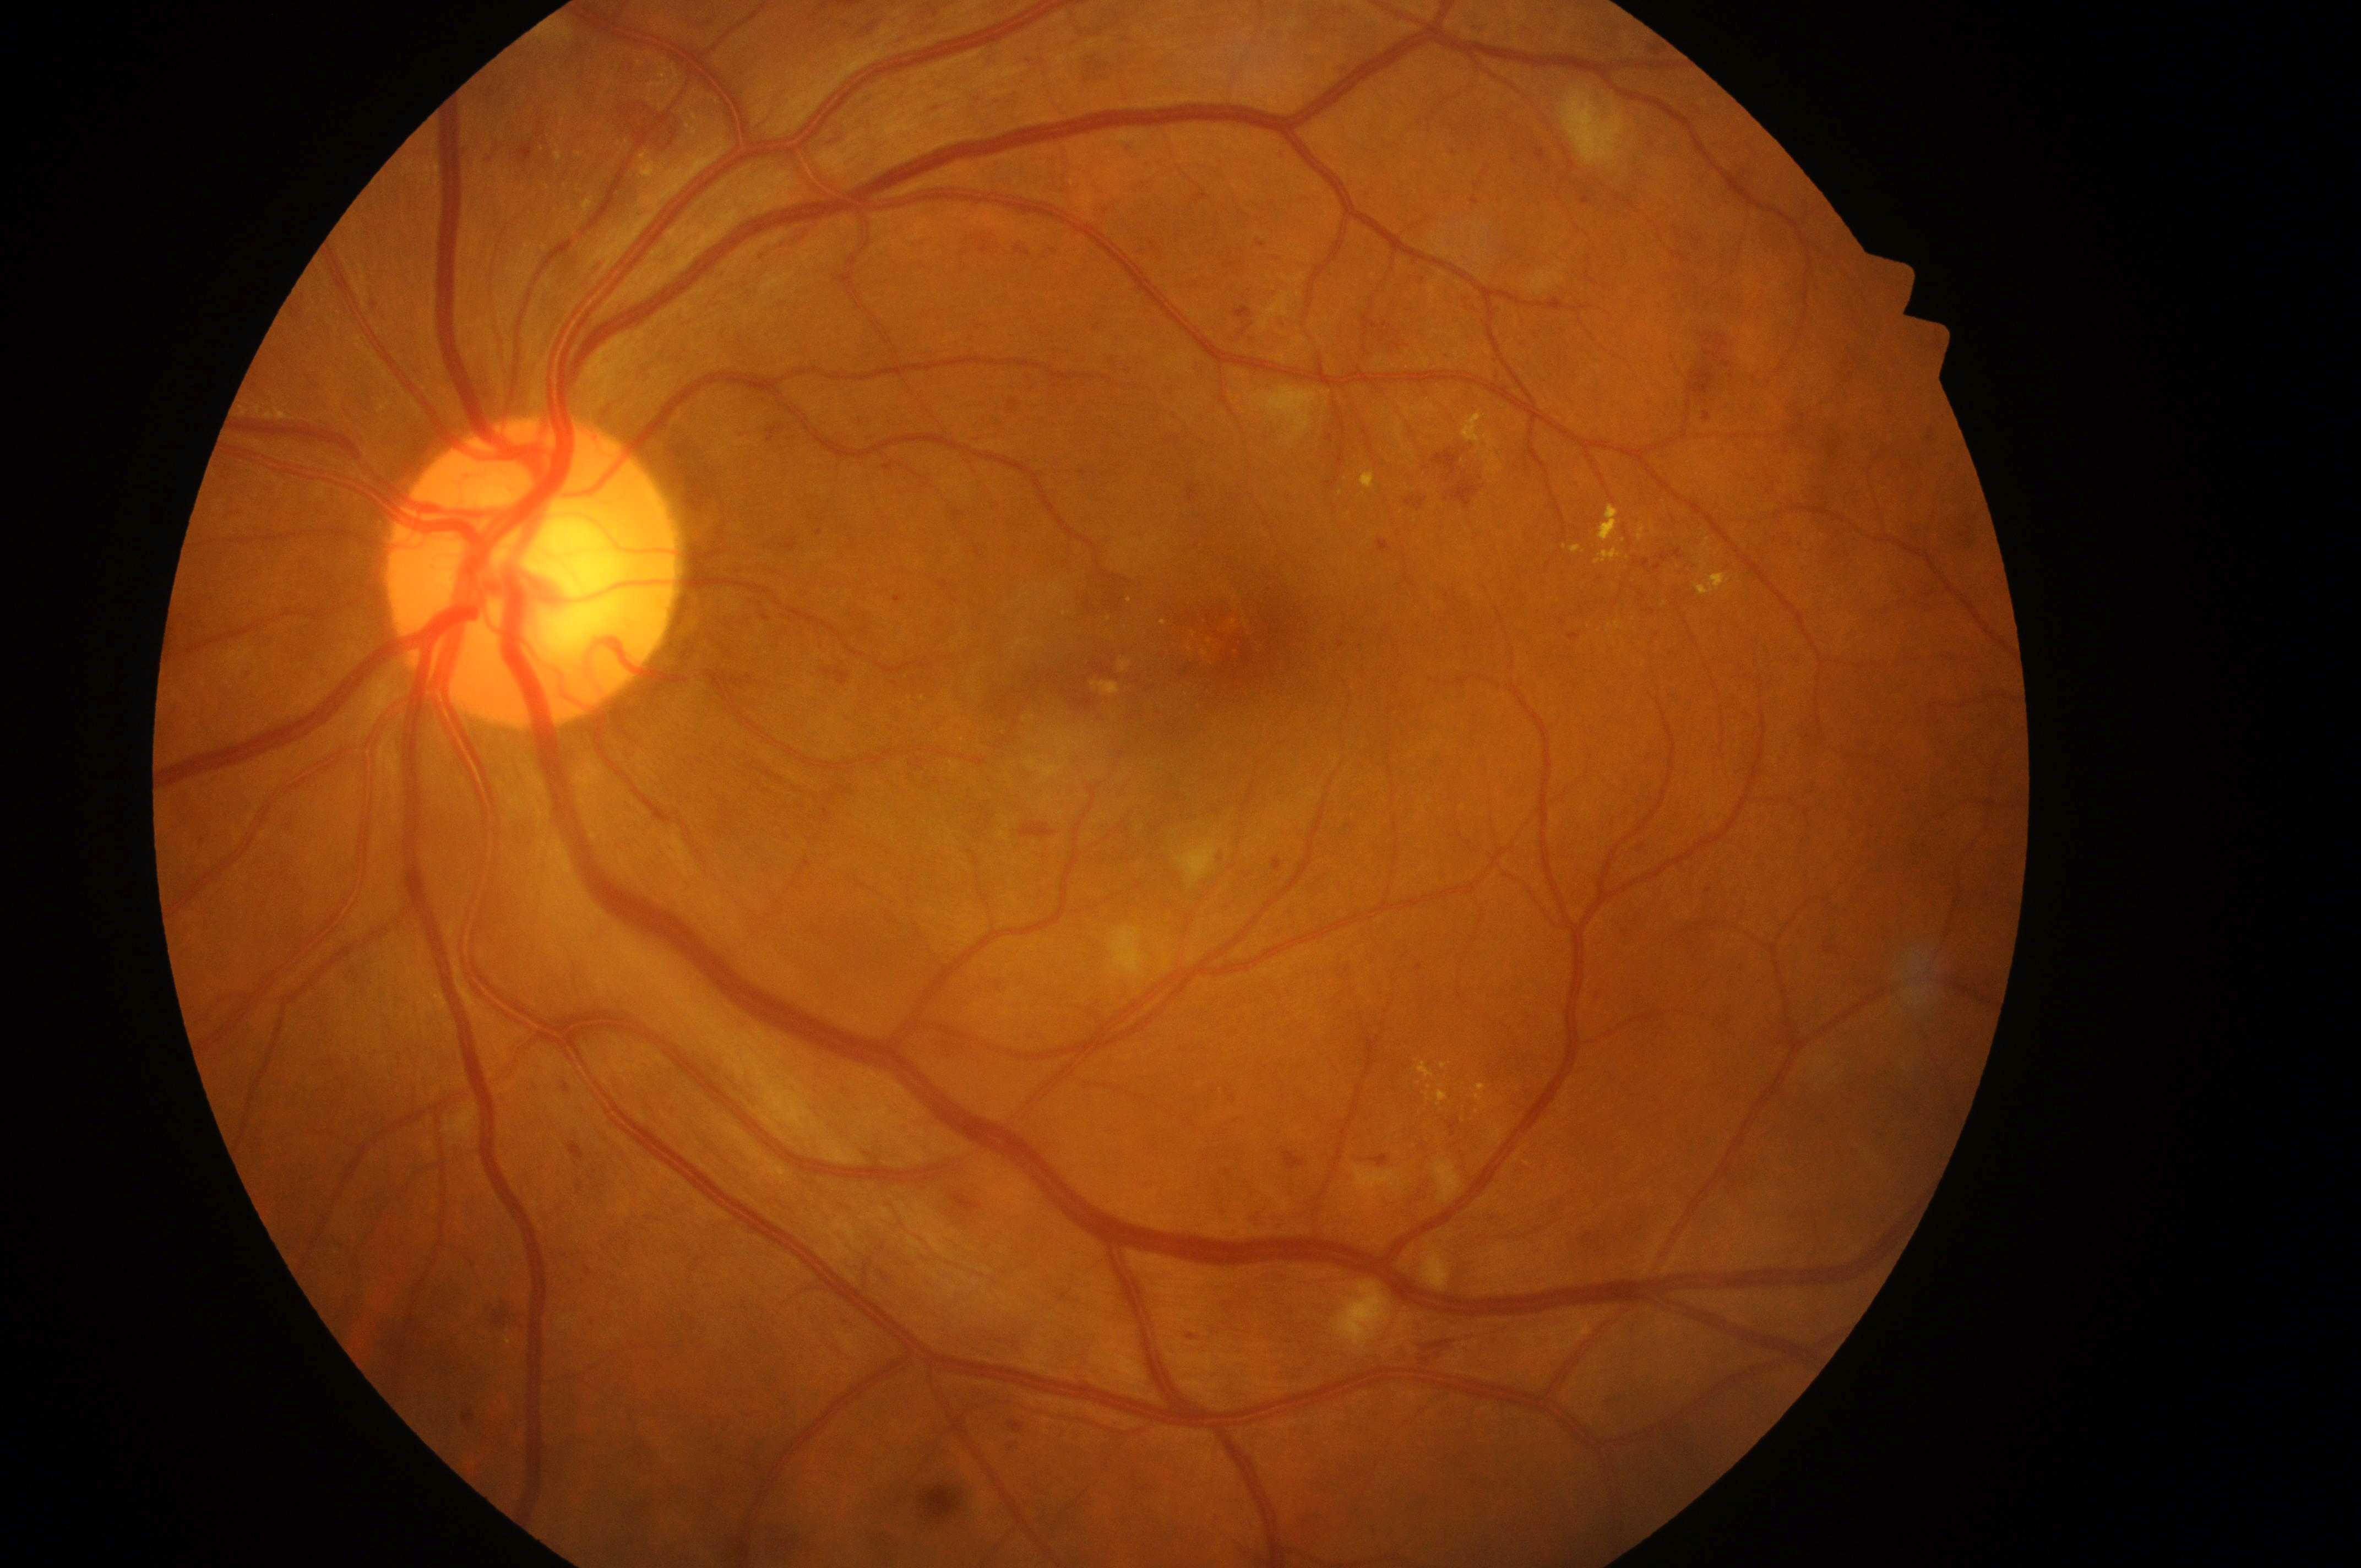 | key | value |
|---|---|
| macula center | 1242px, 635px |
| macular edema | high risk (grade 2) |
| laterality | oculus sinister |
| ONH | 524px, 575px |
| retinopathy grade | 3 (severe NPDR) |